Diabetic retinopathy graded by the modified Davis classification — 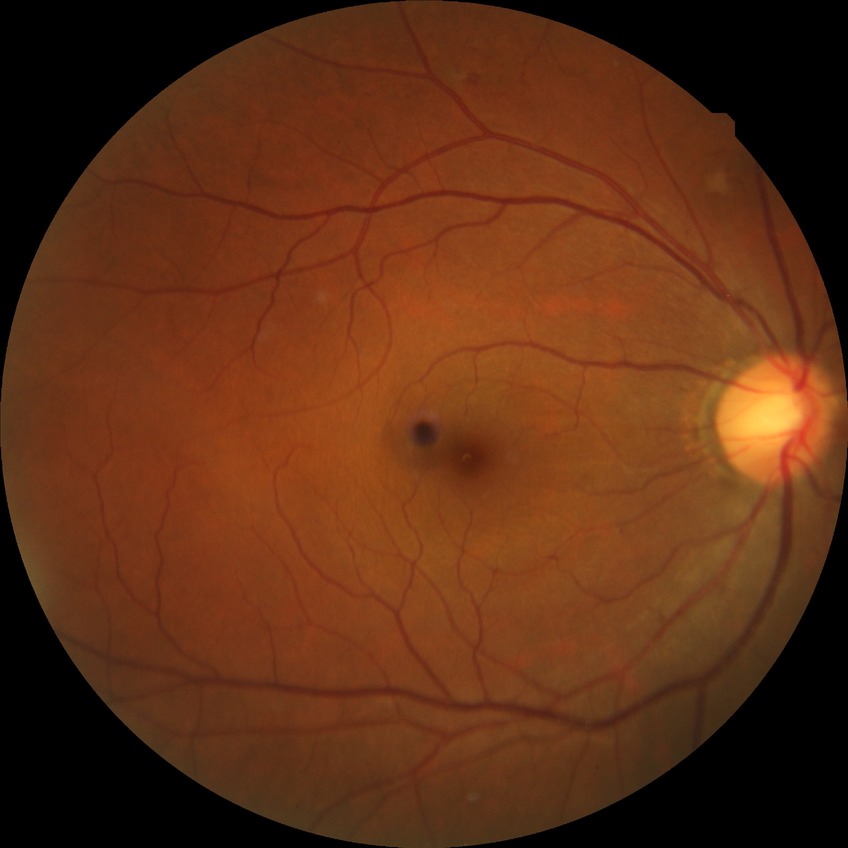
Modified Davis classification: pre-proliferative diabetic retinopathy.